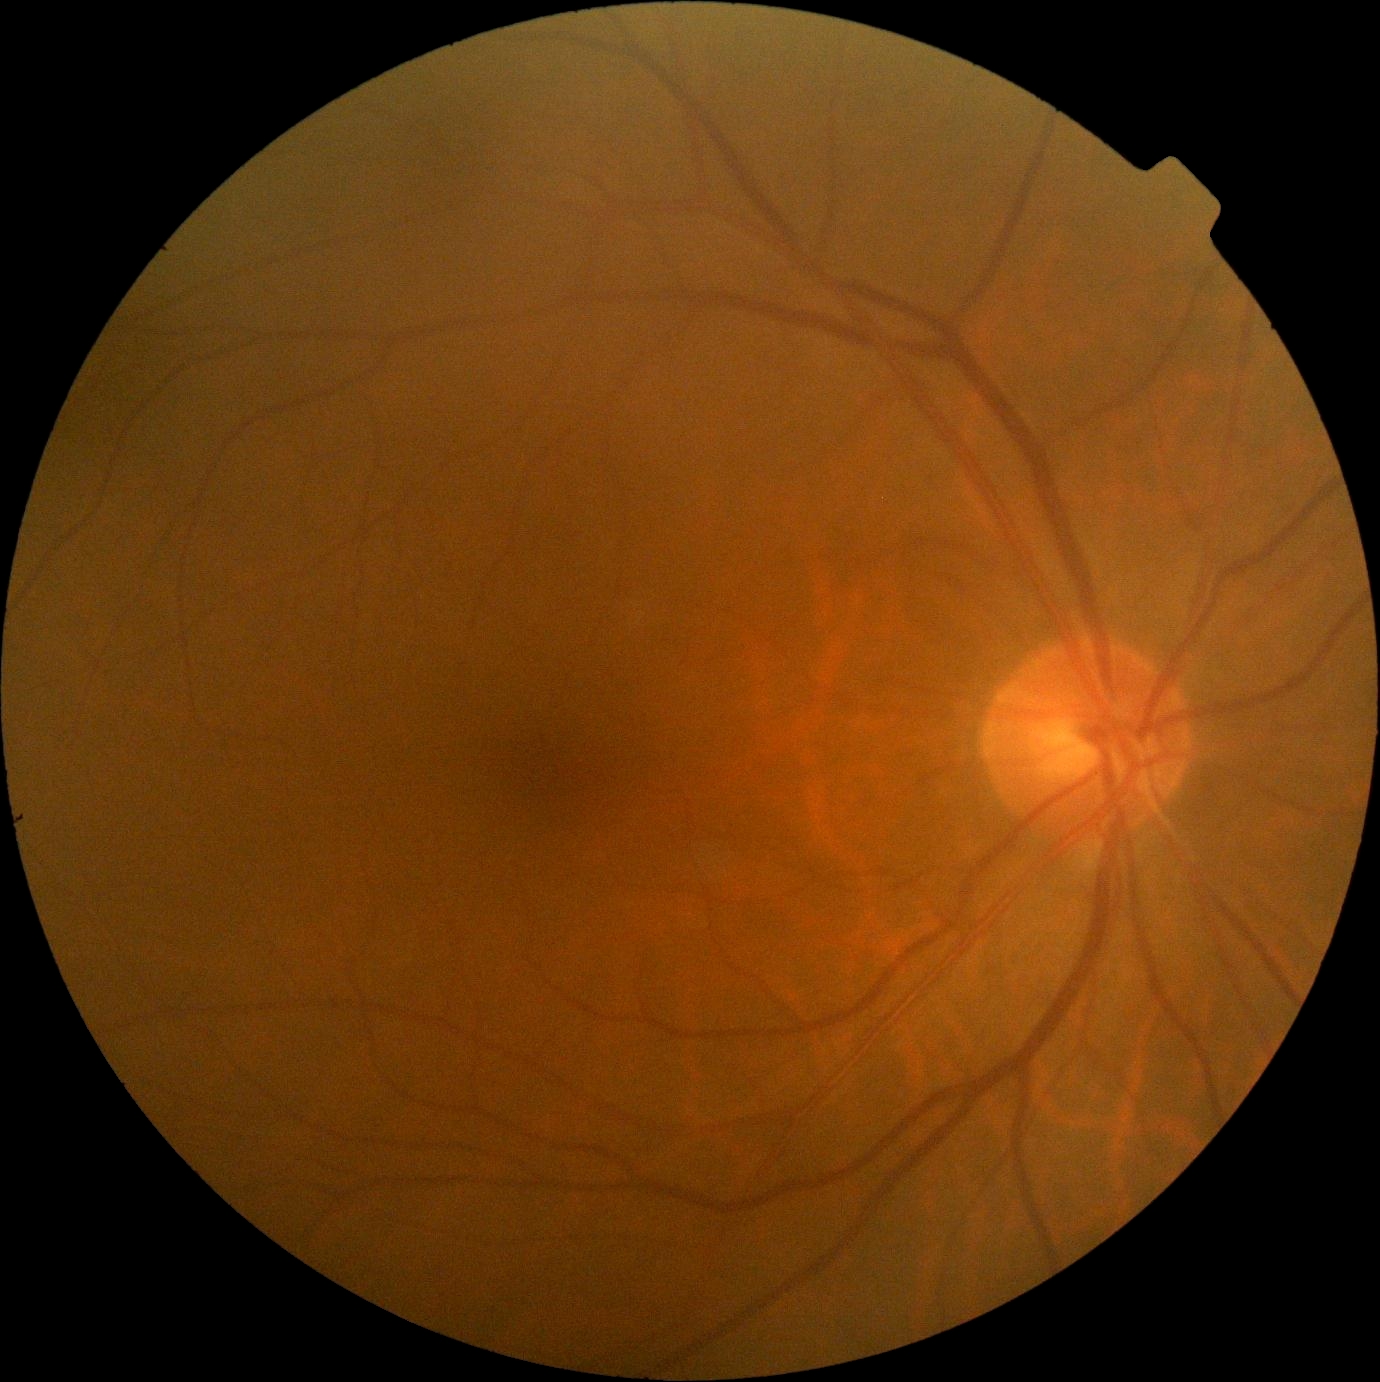 DR@no apparent retinopathy (grade 0).